Color fundus photograph.
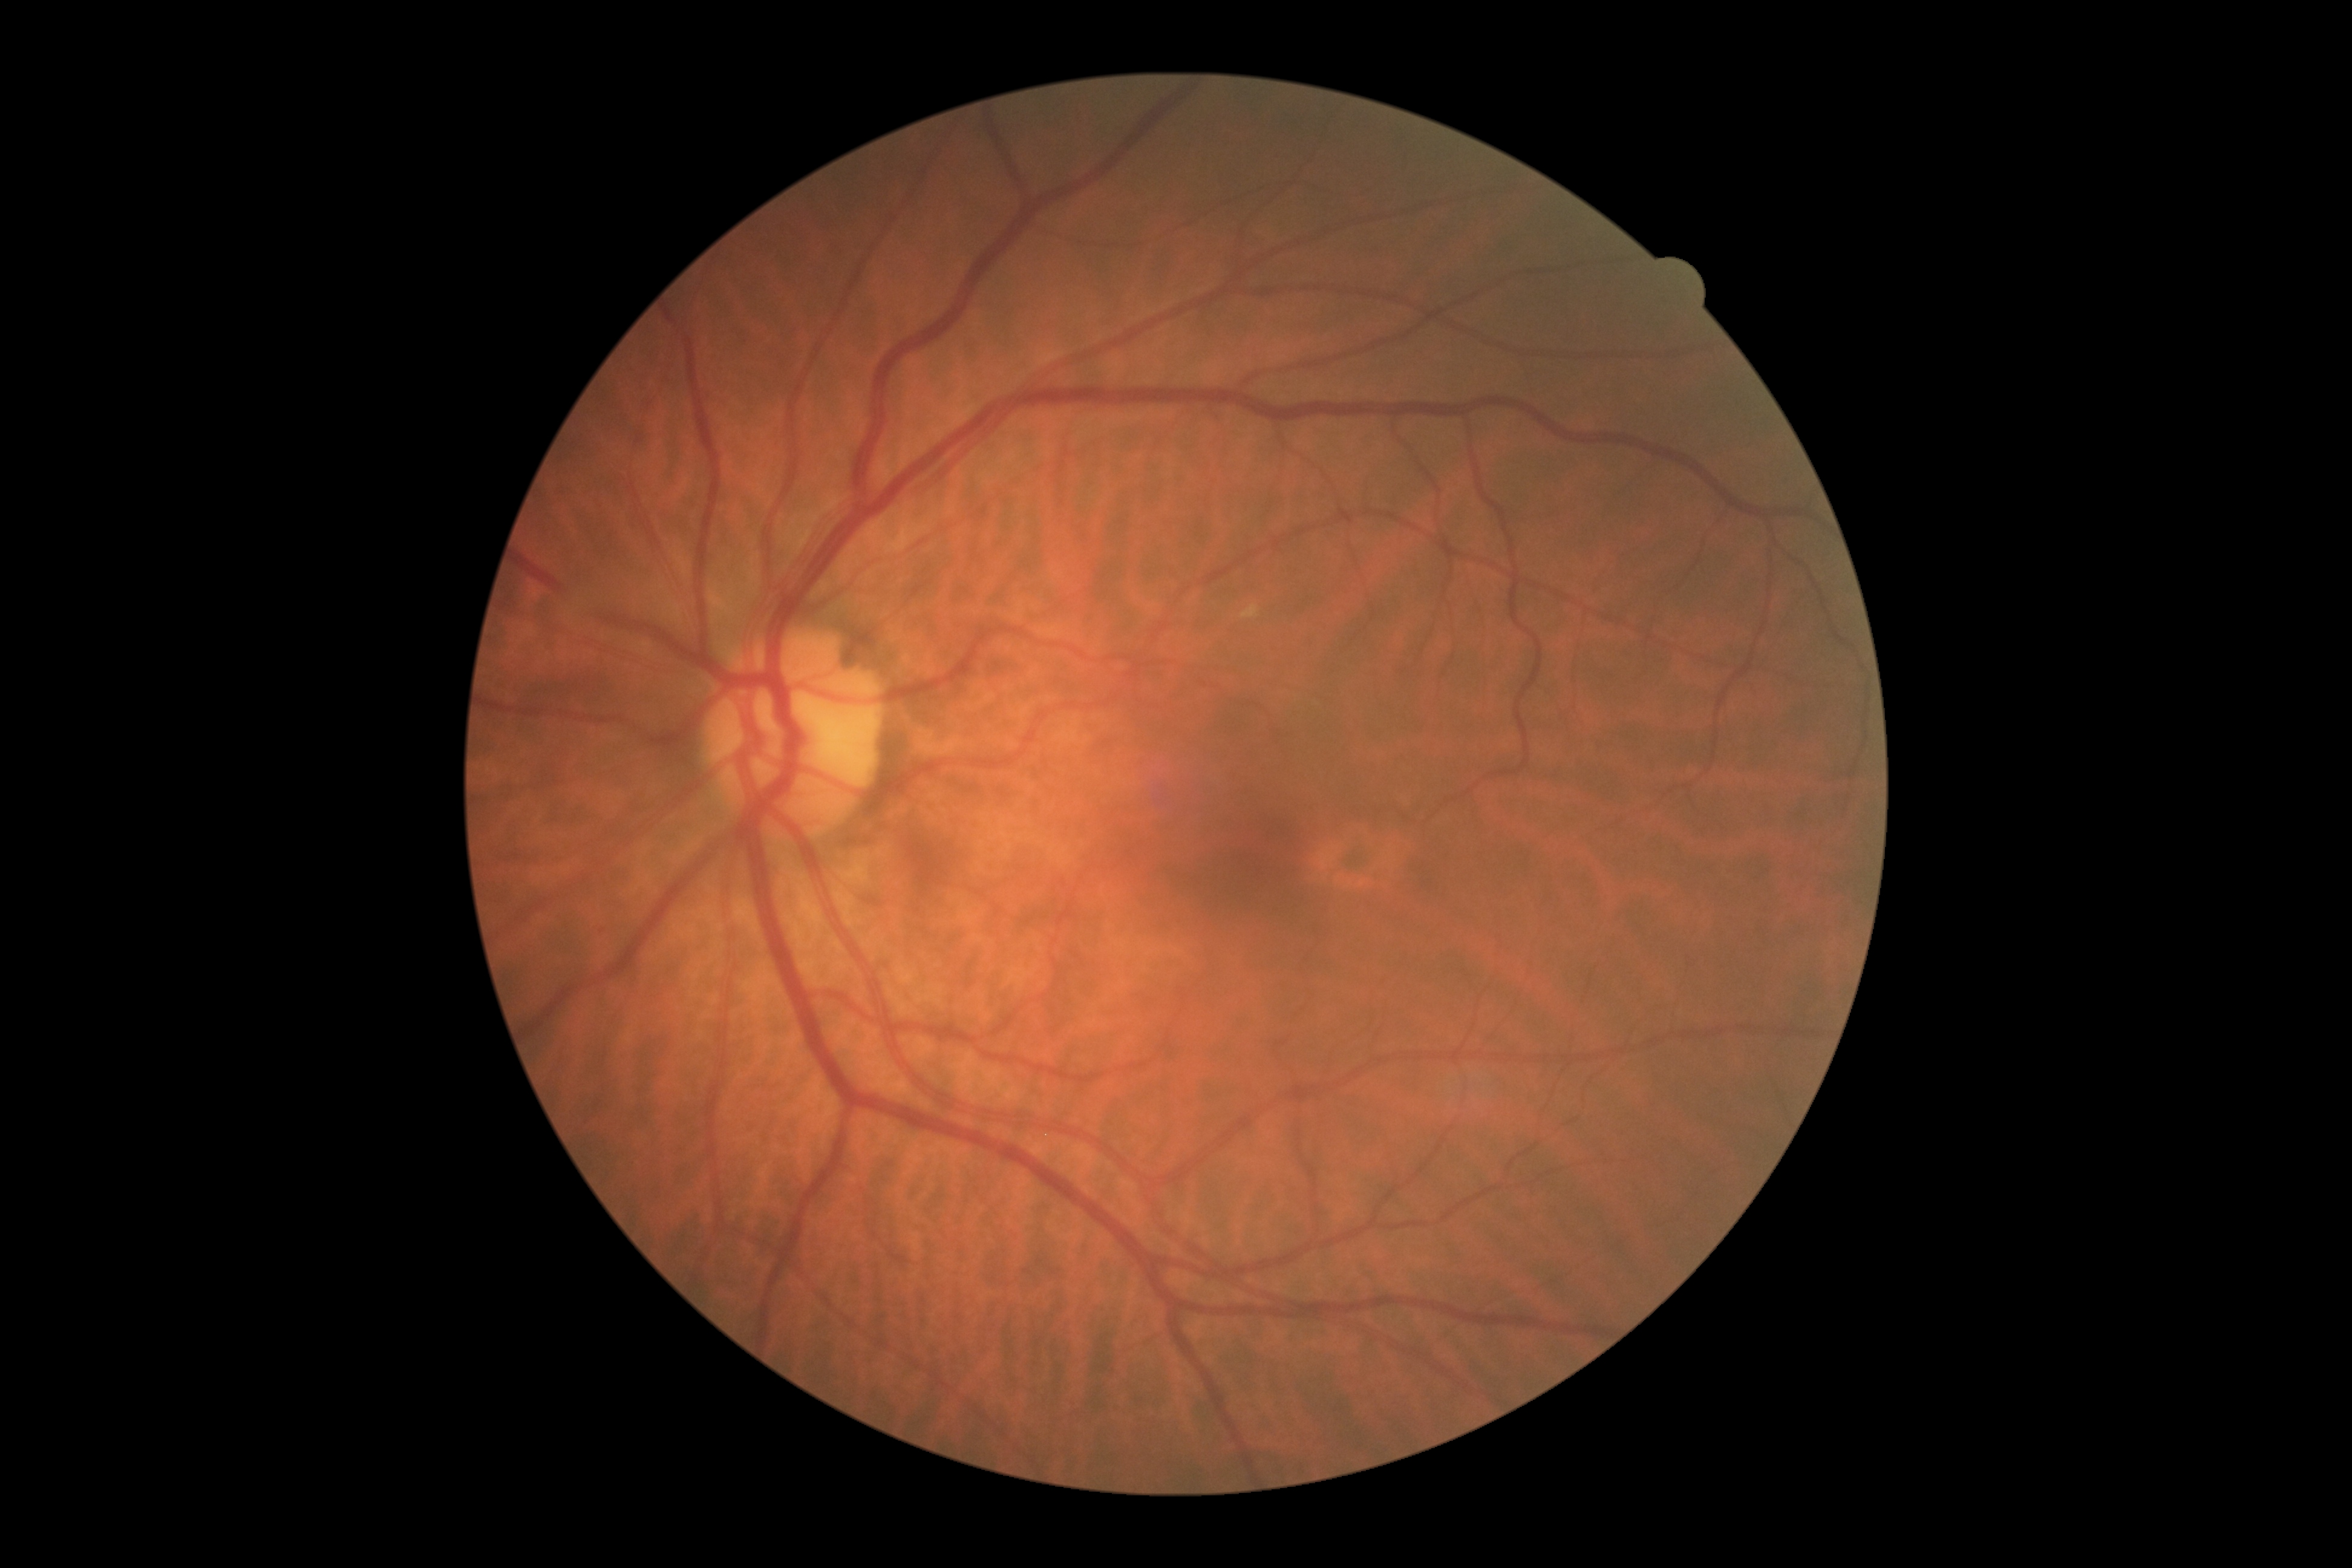

Diabetic retinopathy (DR): 0/4.